45° field of view: 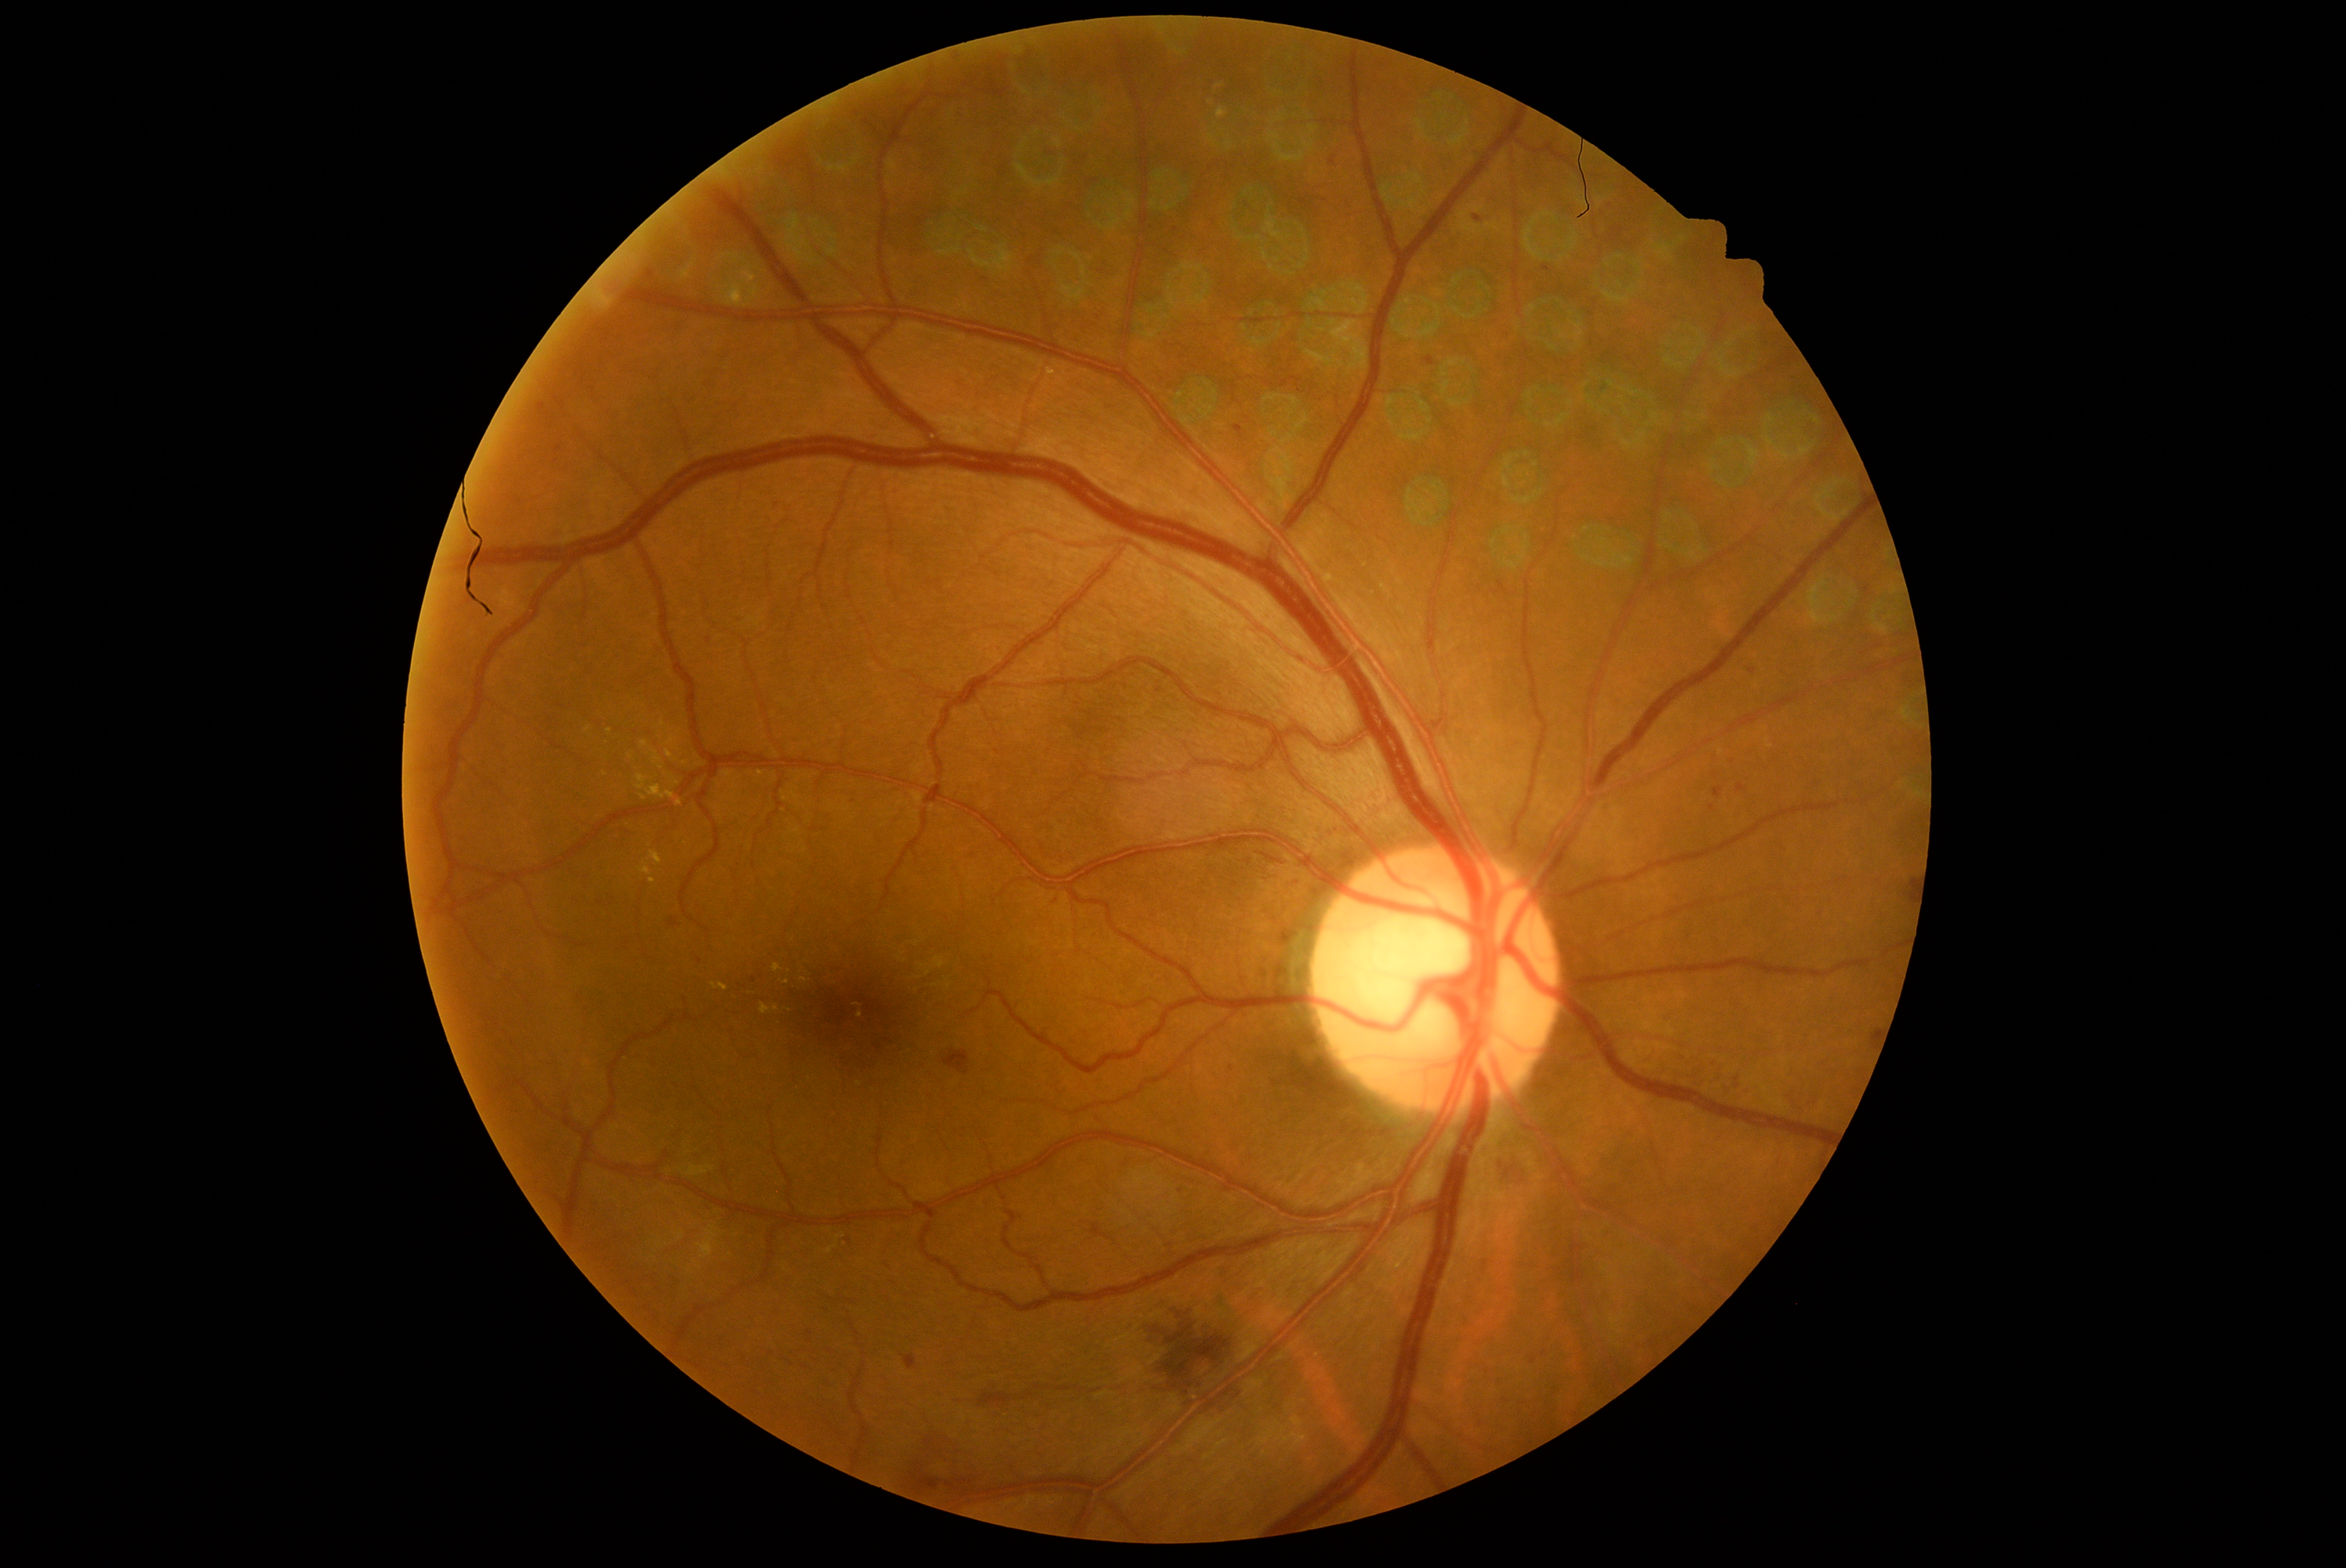
DR severity is grade 2 (moderate NPDR).